2048x1536px:
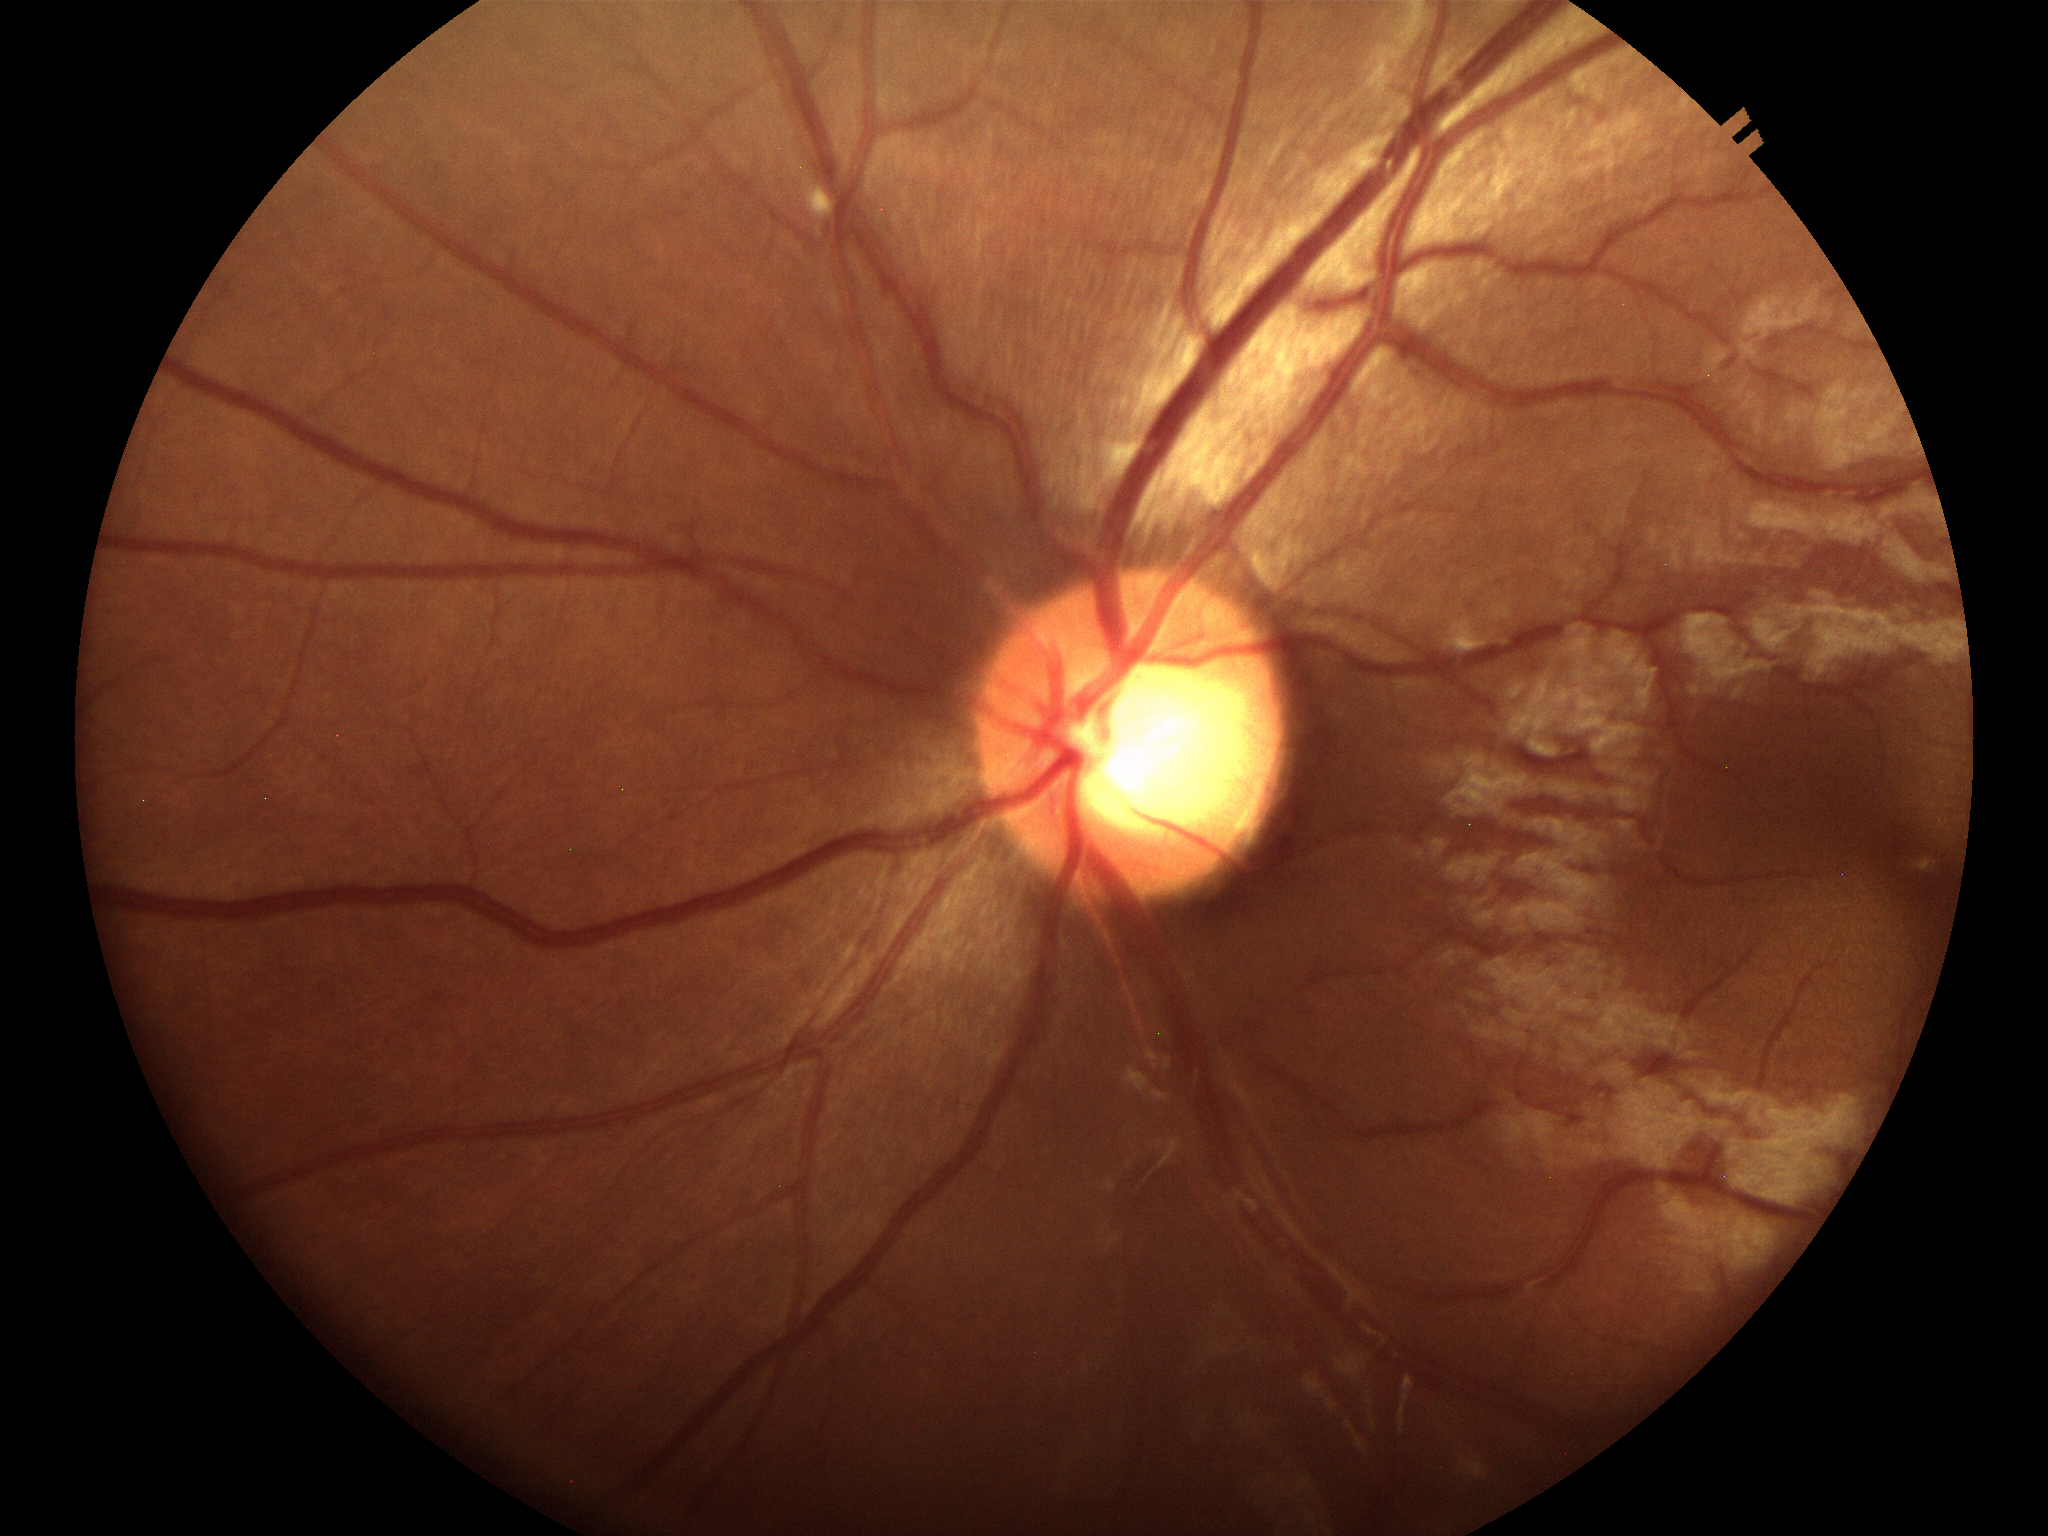

horizontal cup-to-disc ratio=0.63
vertical C/D ratio=0.56
Glaucoma screening=negative (one of five ophthalmologists flagged glaucoma suspect)